NIDEK AFC-230: 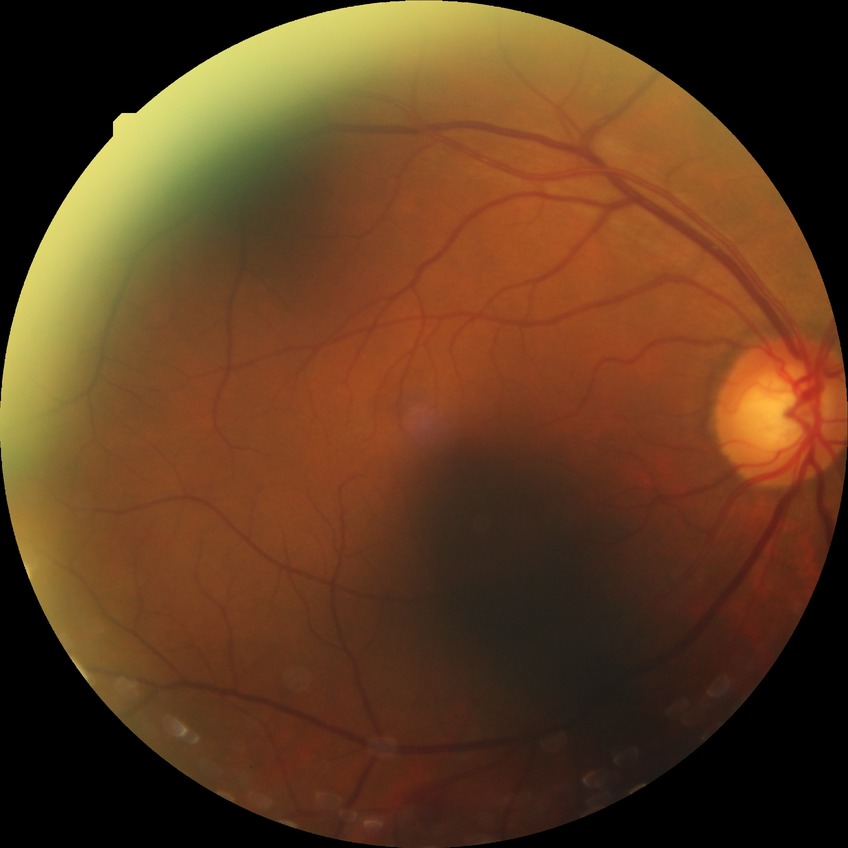
The retinopathy is classified as non-proliferative diabetic retinopathy. Davis DR grade: SDR.